DR severity per modified Davis staging:
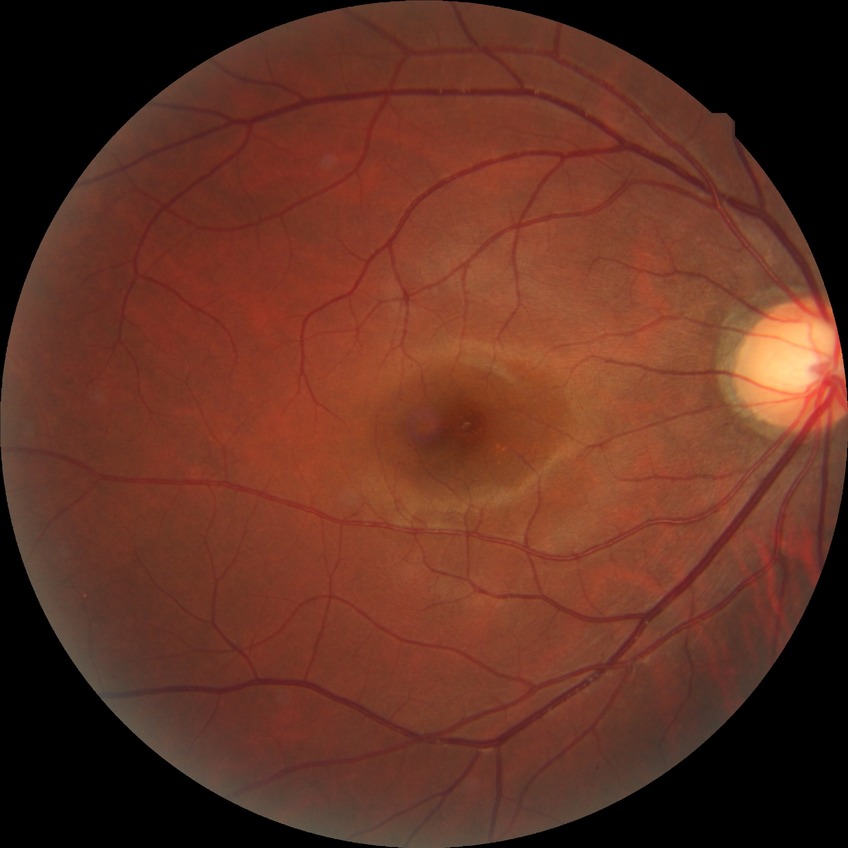
  davis_grade: NDR (no diabetic retinopathy)